Color fundus image: 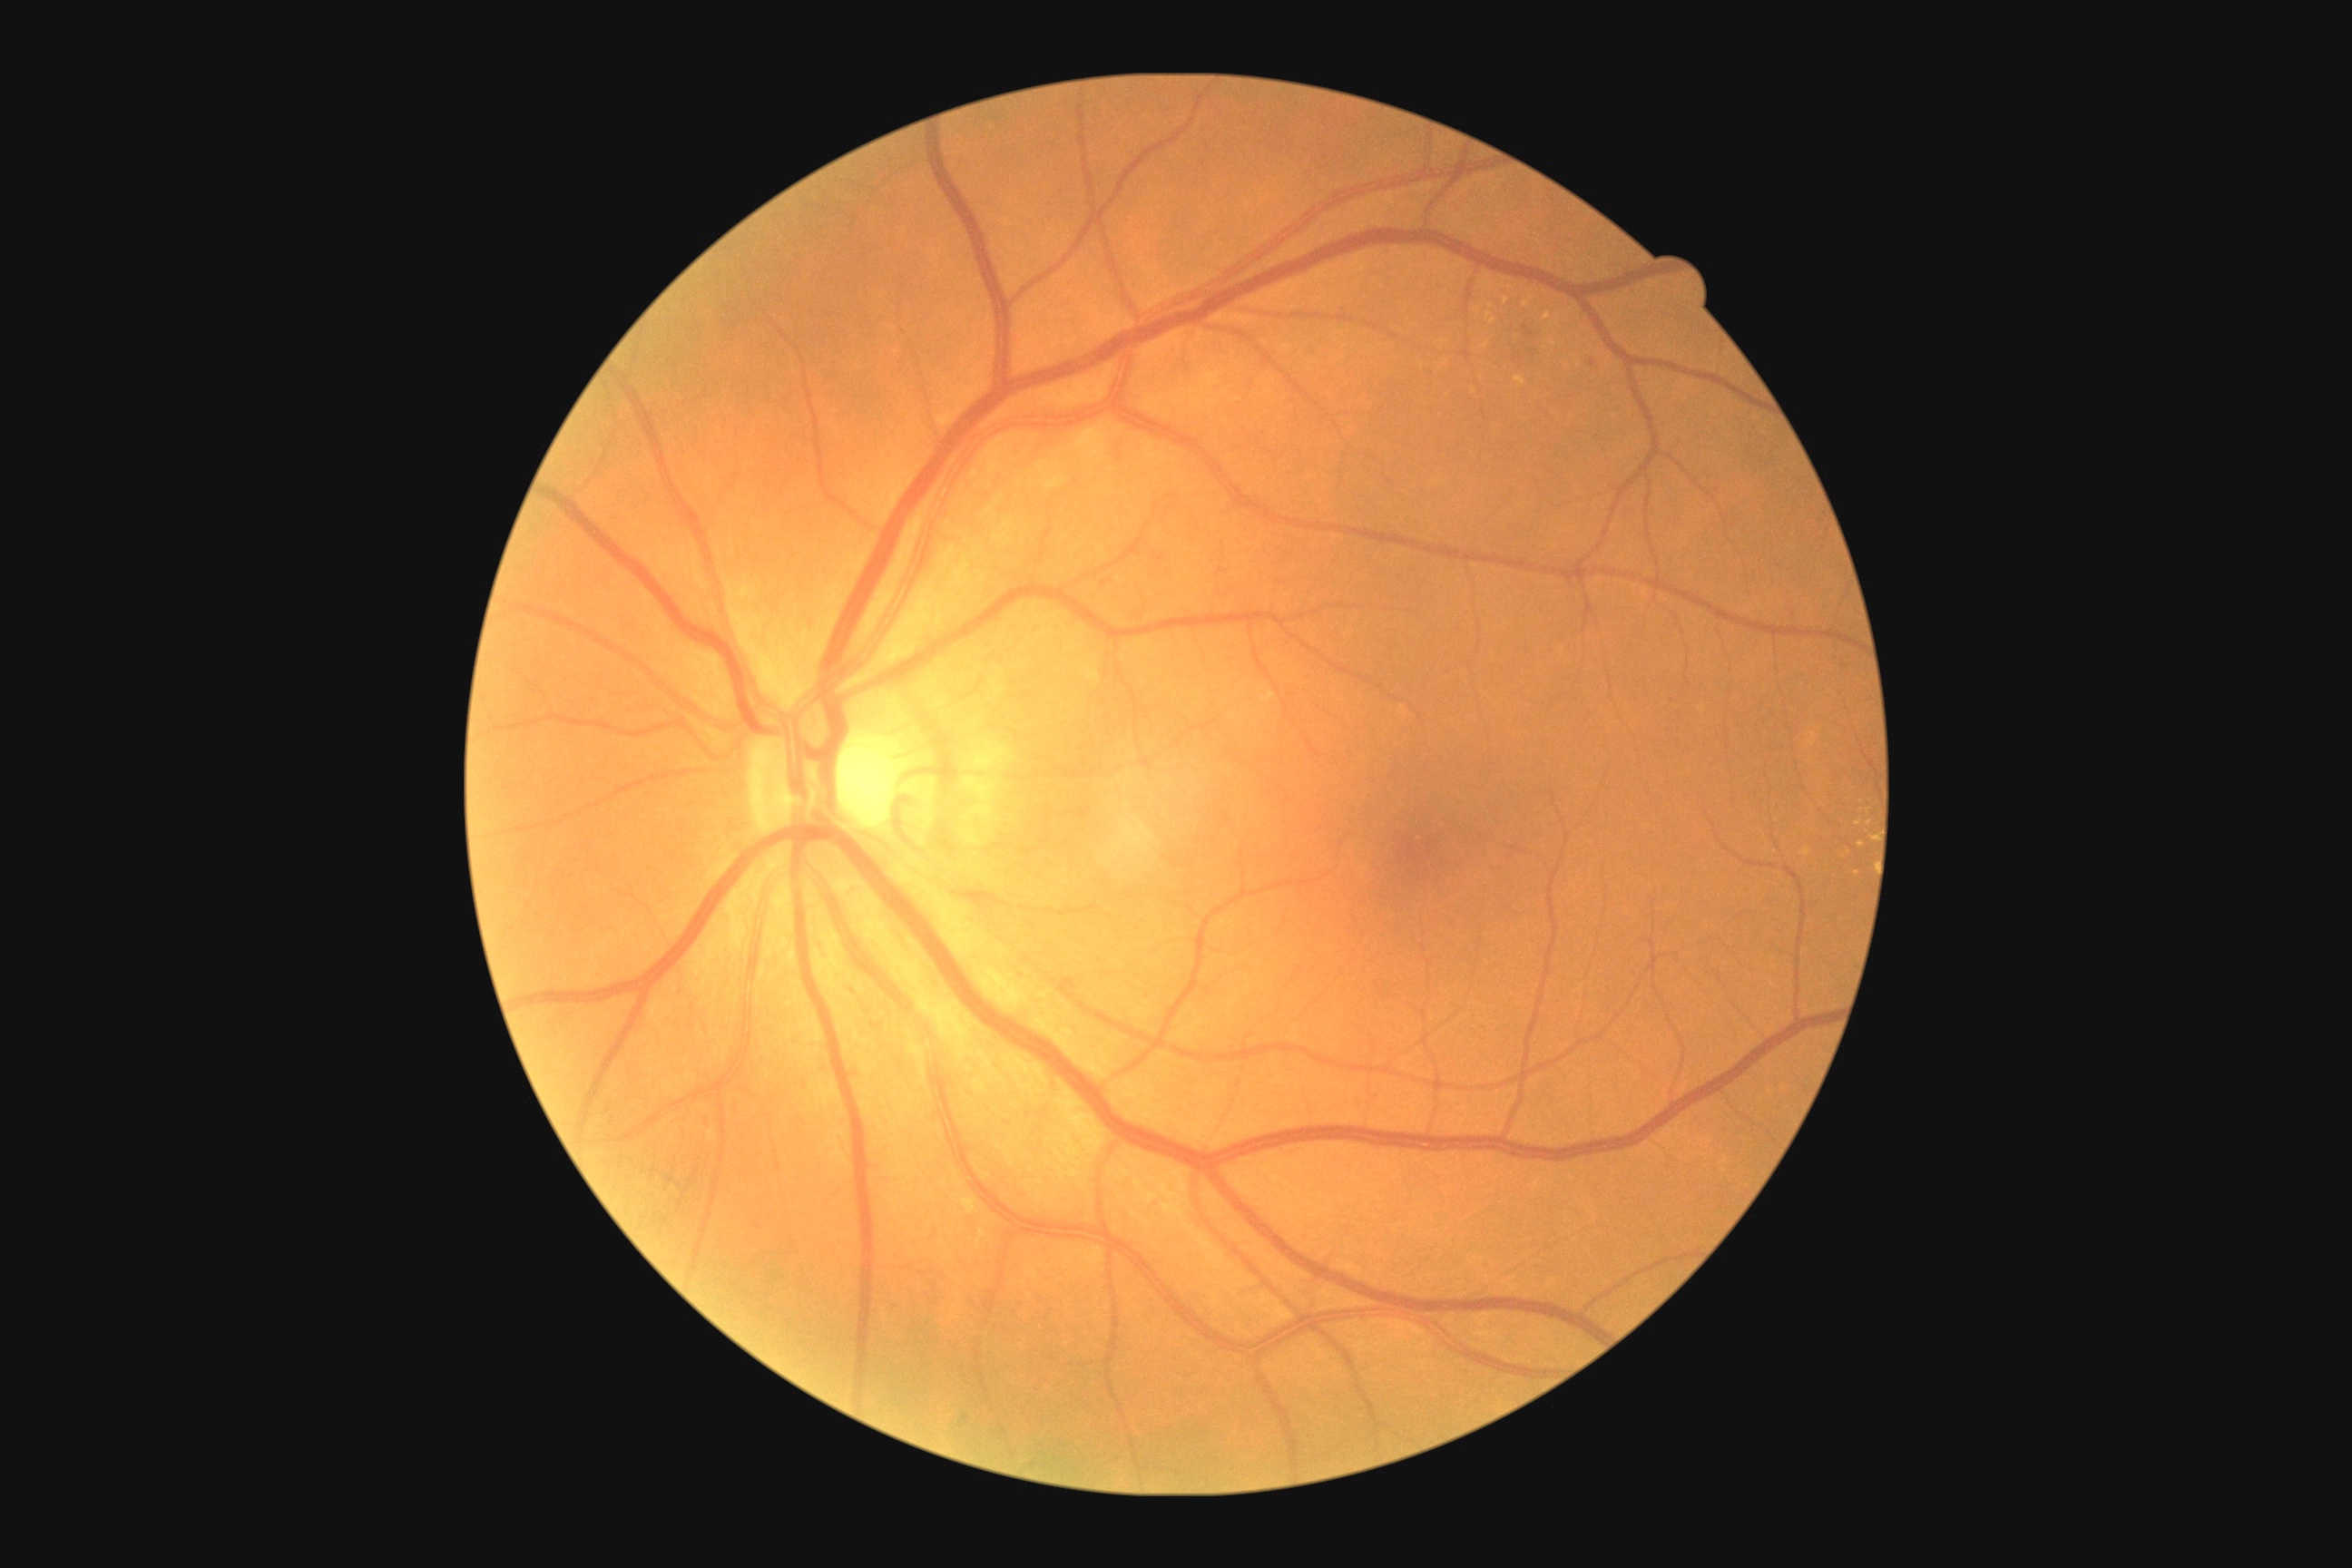

Diabetic retinopathy (DR): moderate NPDR (grade 2)
Selected lesions:
- hard exudates (EXs) (continued): [1504,297,1509,306], [1482,275,1494,291], [1803,847,1810,856], [1514,377,1527,389], [1524,295,1534,308]
- Small EXs approximately at [x=1486, y=346], [x=1489, y=315], [x=1857, y=873], [x=1862, y=844], [x=1491, y=307]